Camera: Clarity RetCam 3 (130° FOV); 640x480px; infant wide-field retinal image
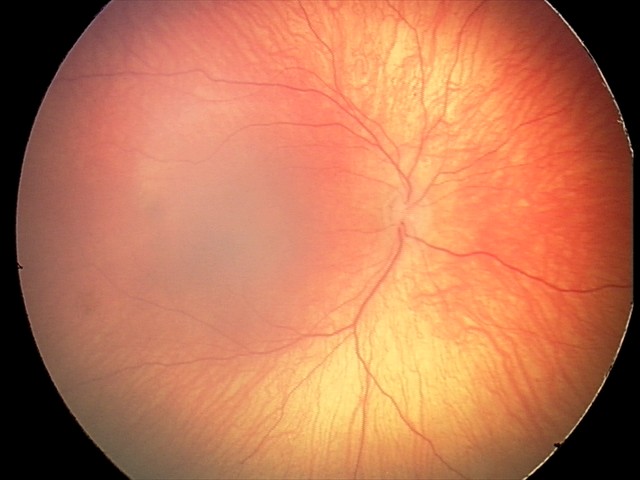
Assessment: normal retinal appearance